2212x1672px.
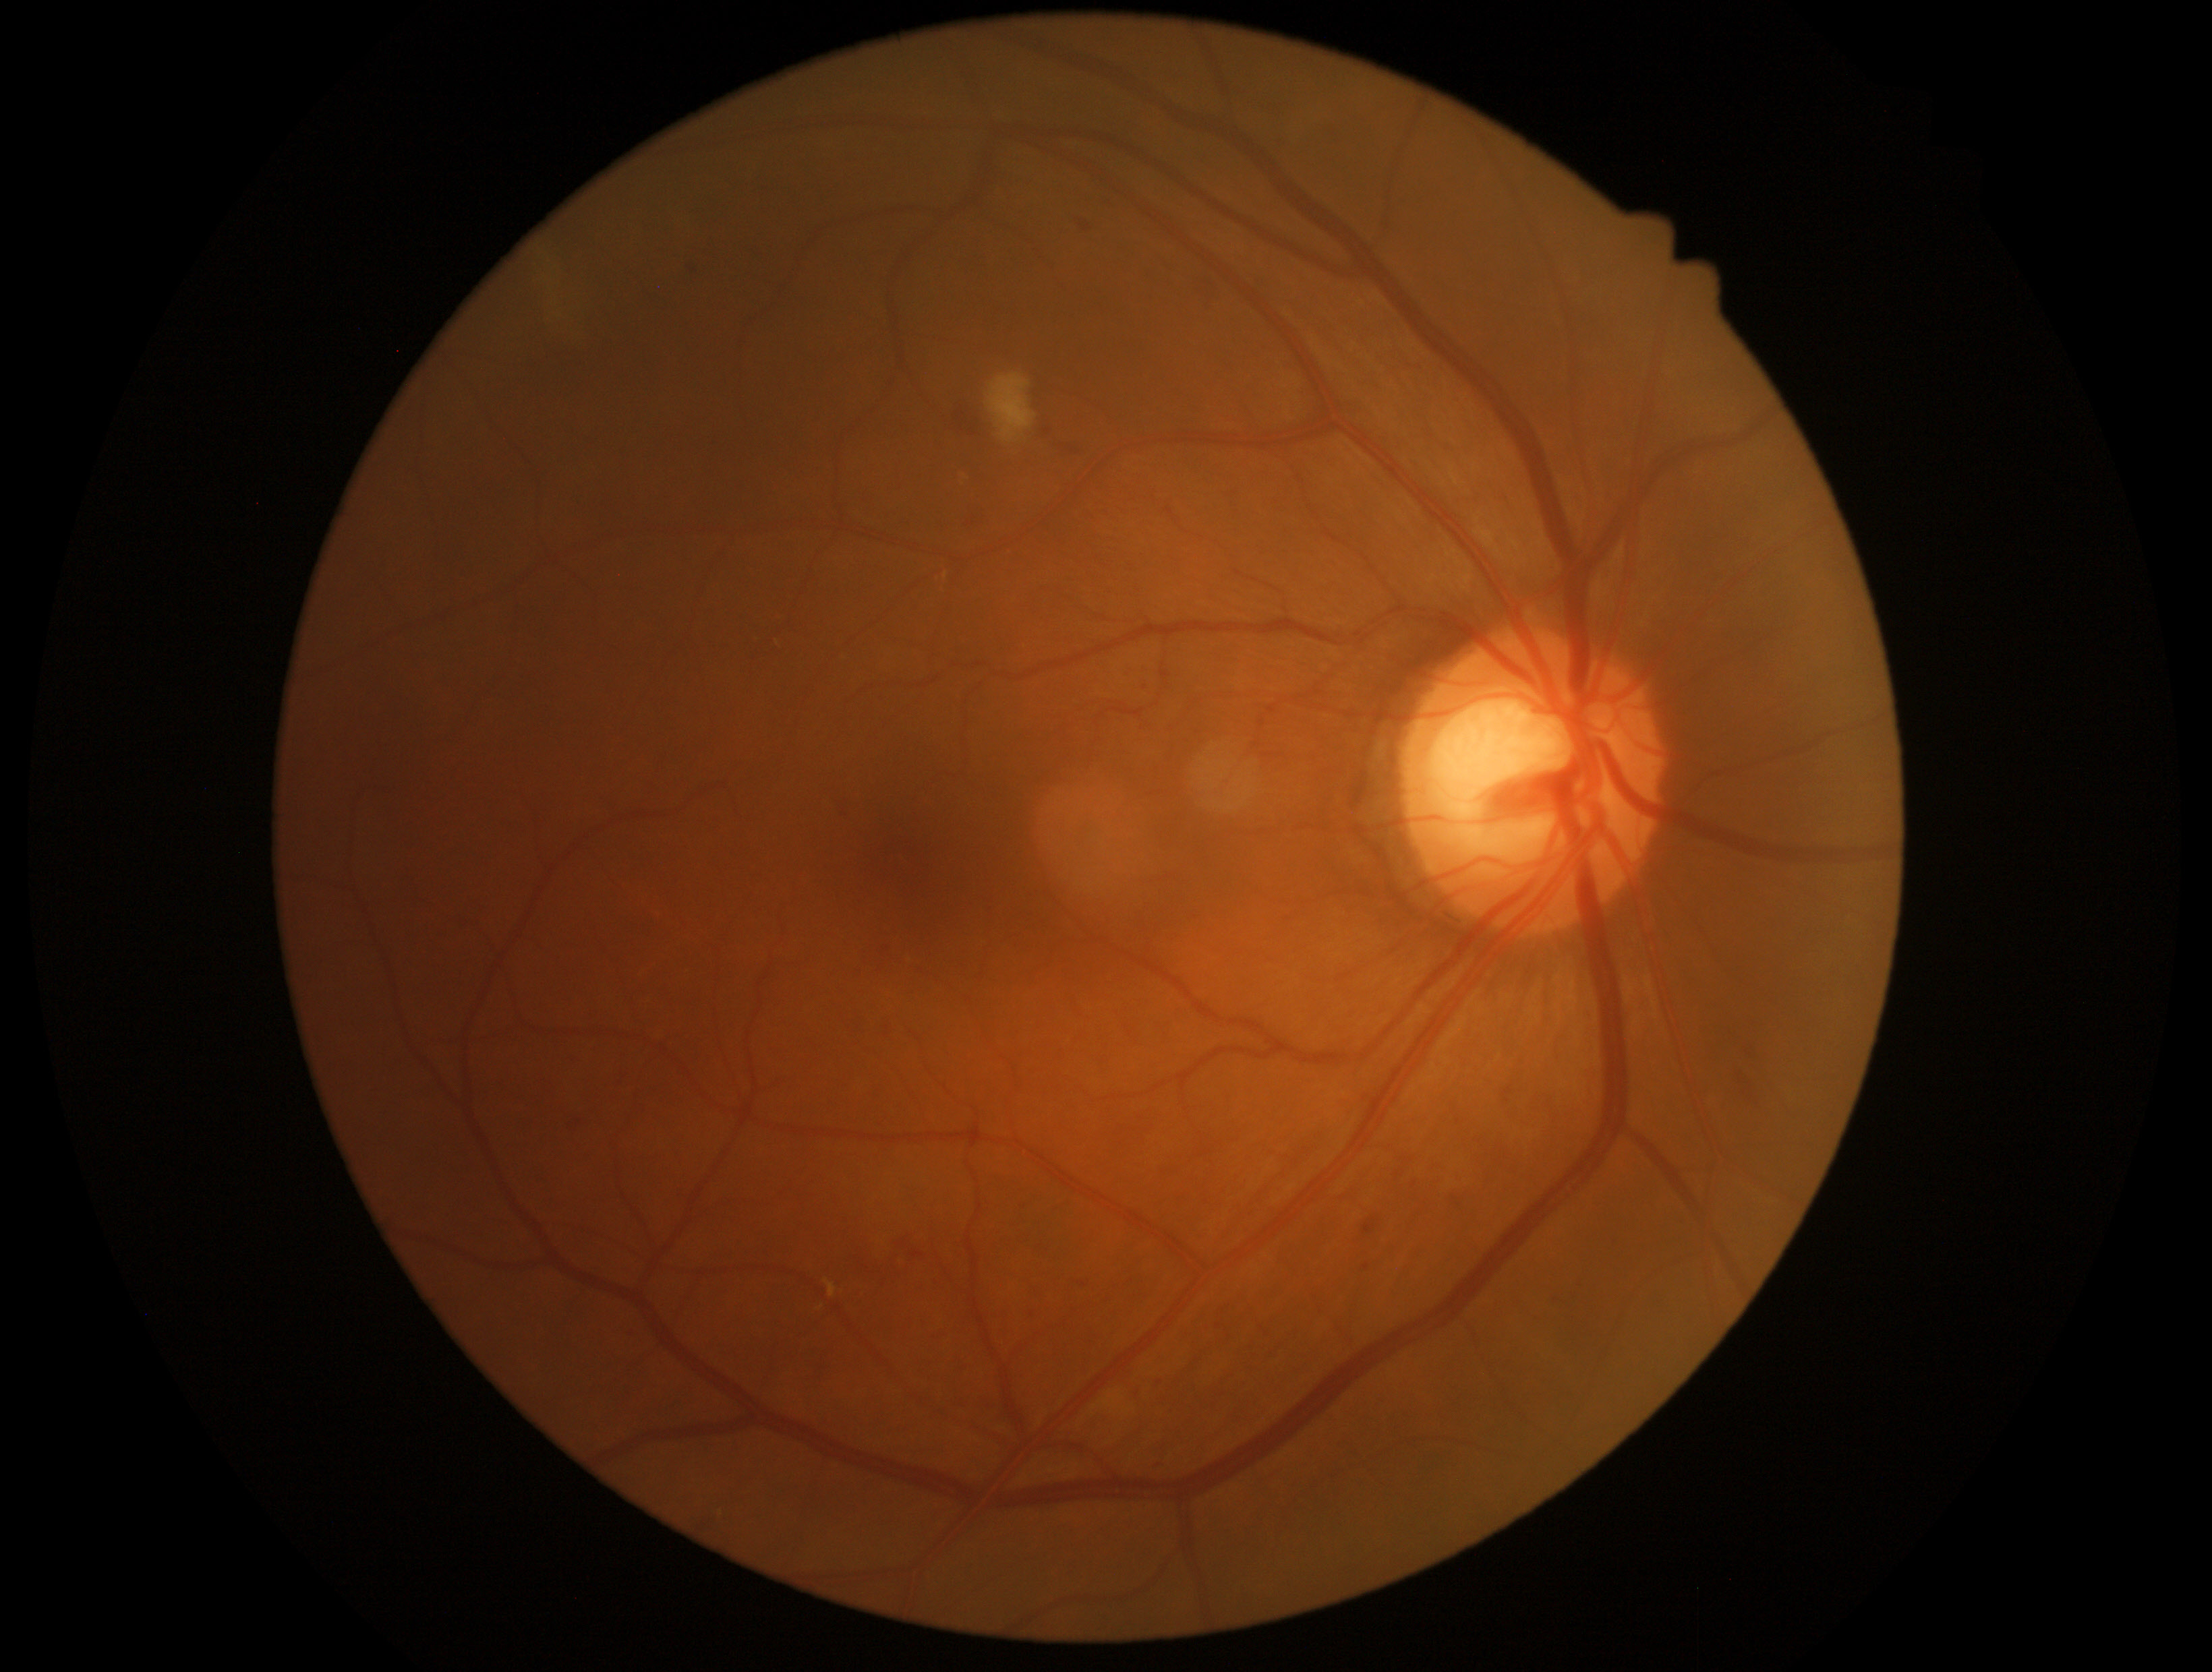
The retinopathy is classified as non-proliferative diabetic retinopathy. DR grade: 2.